2212 by 1659 pixels. Portable fundus photograph. 60° field of view: 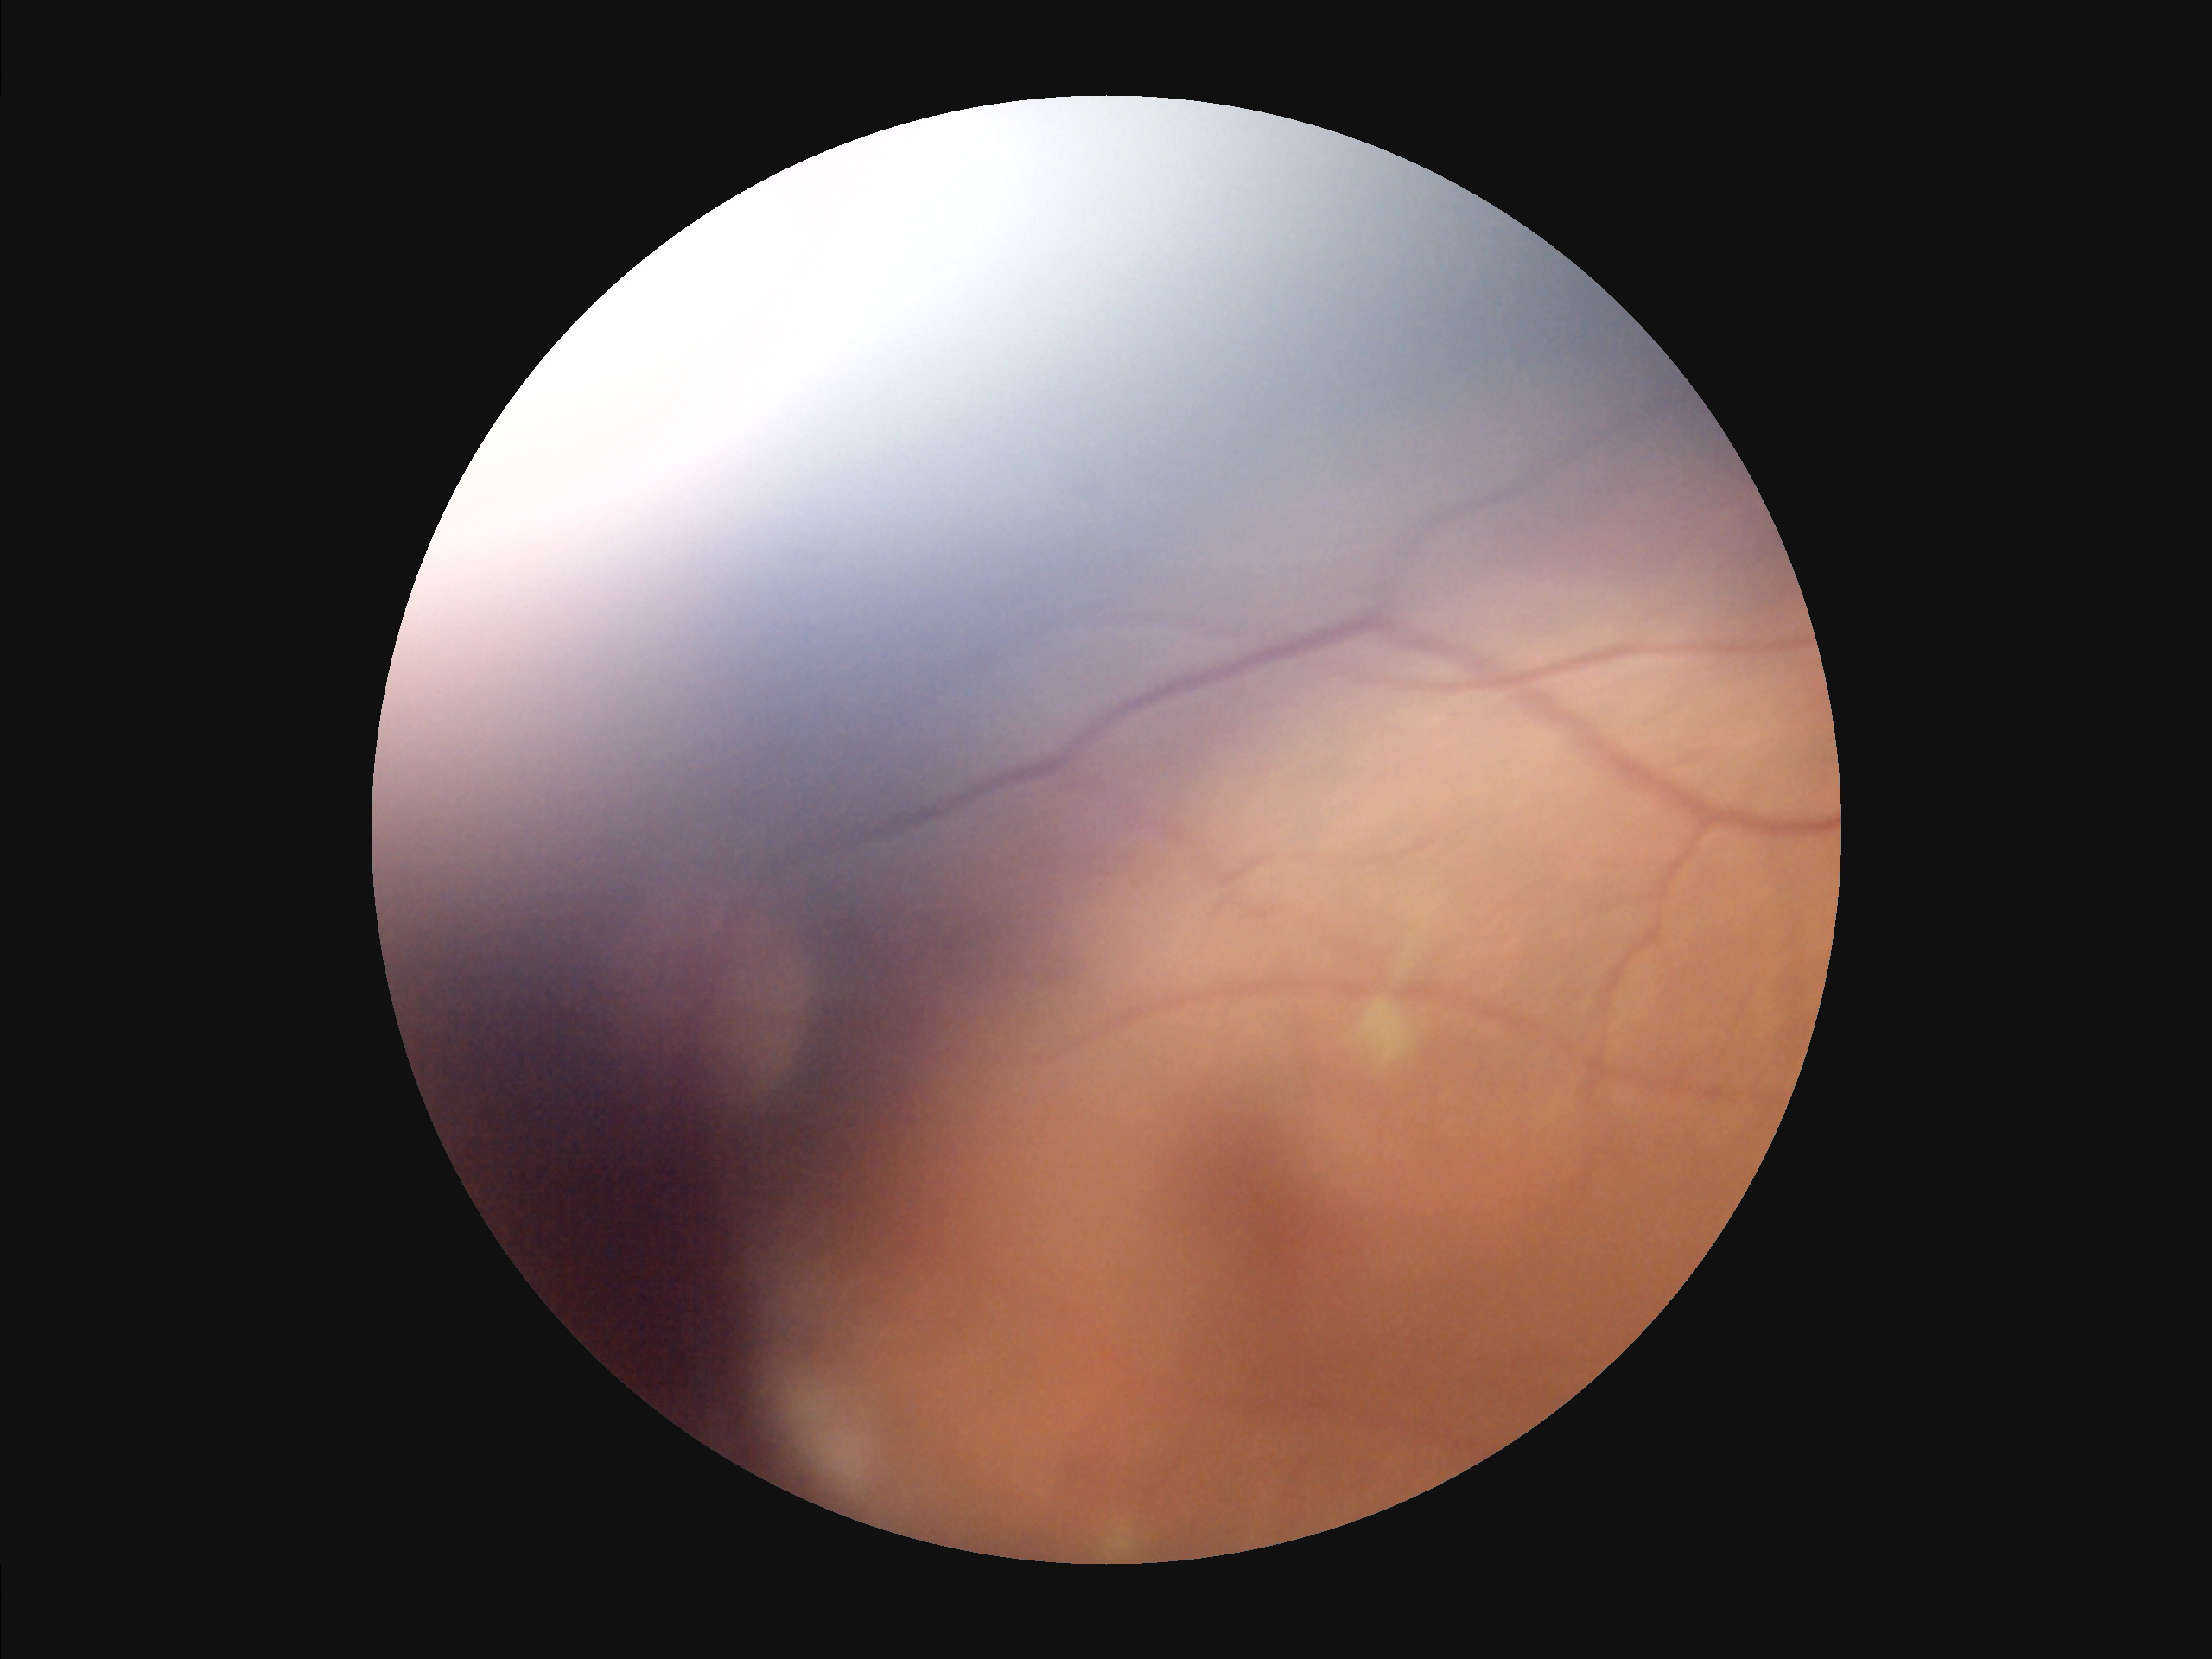 The image is blurry.
Narrow intensity range; structures are hard to distinguish.
Image quality is suboptimal.
There is over- or under-exposure or a color cast.